Color fundus photograph · 2212 by 1659 pixels:
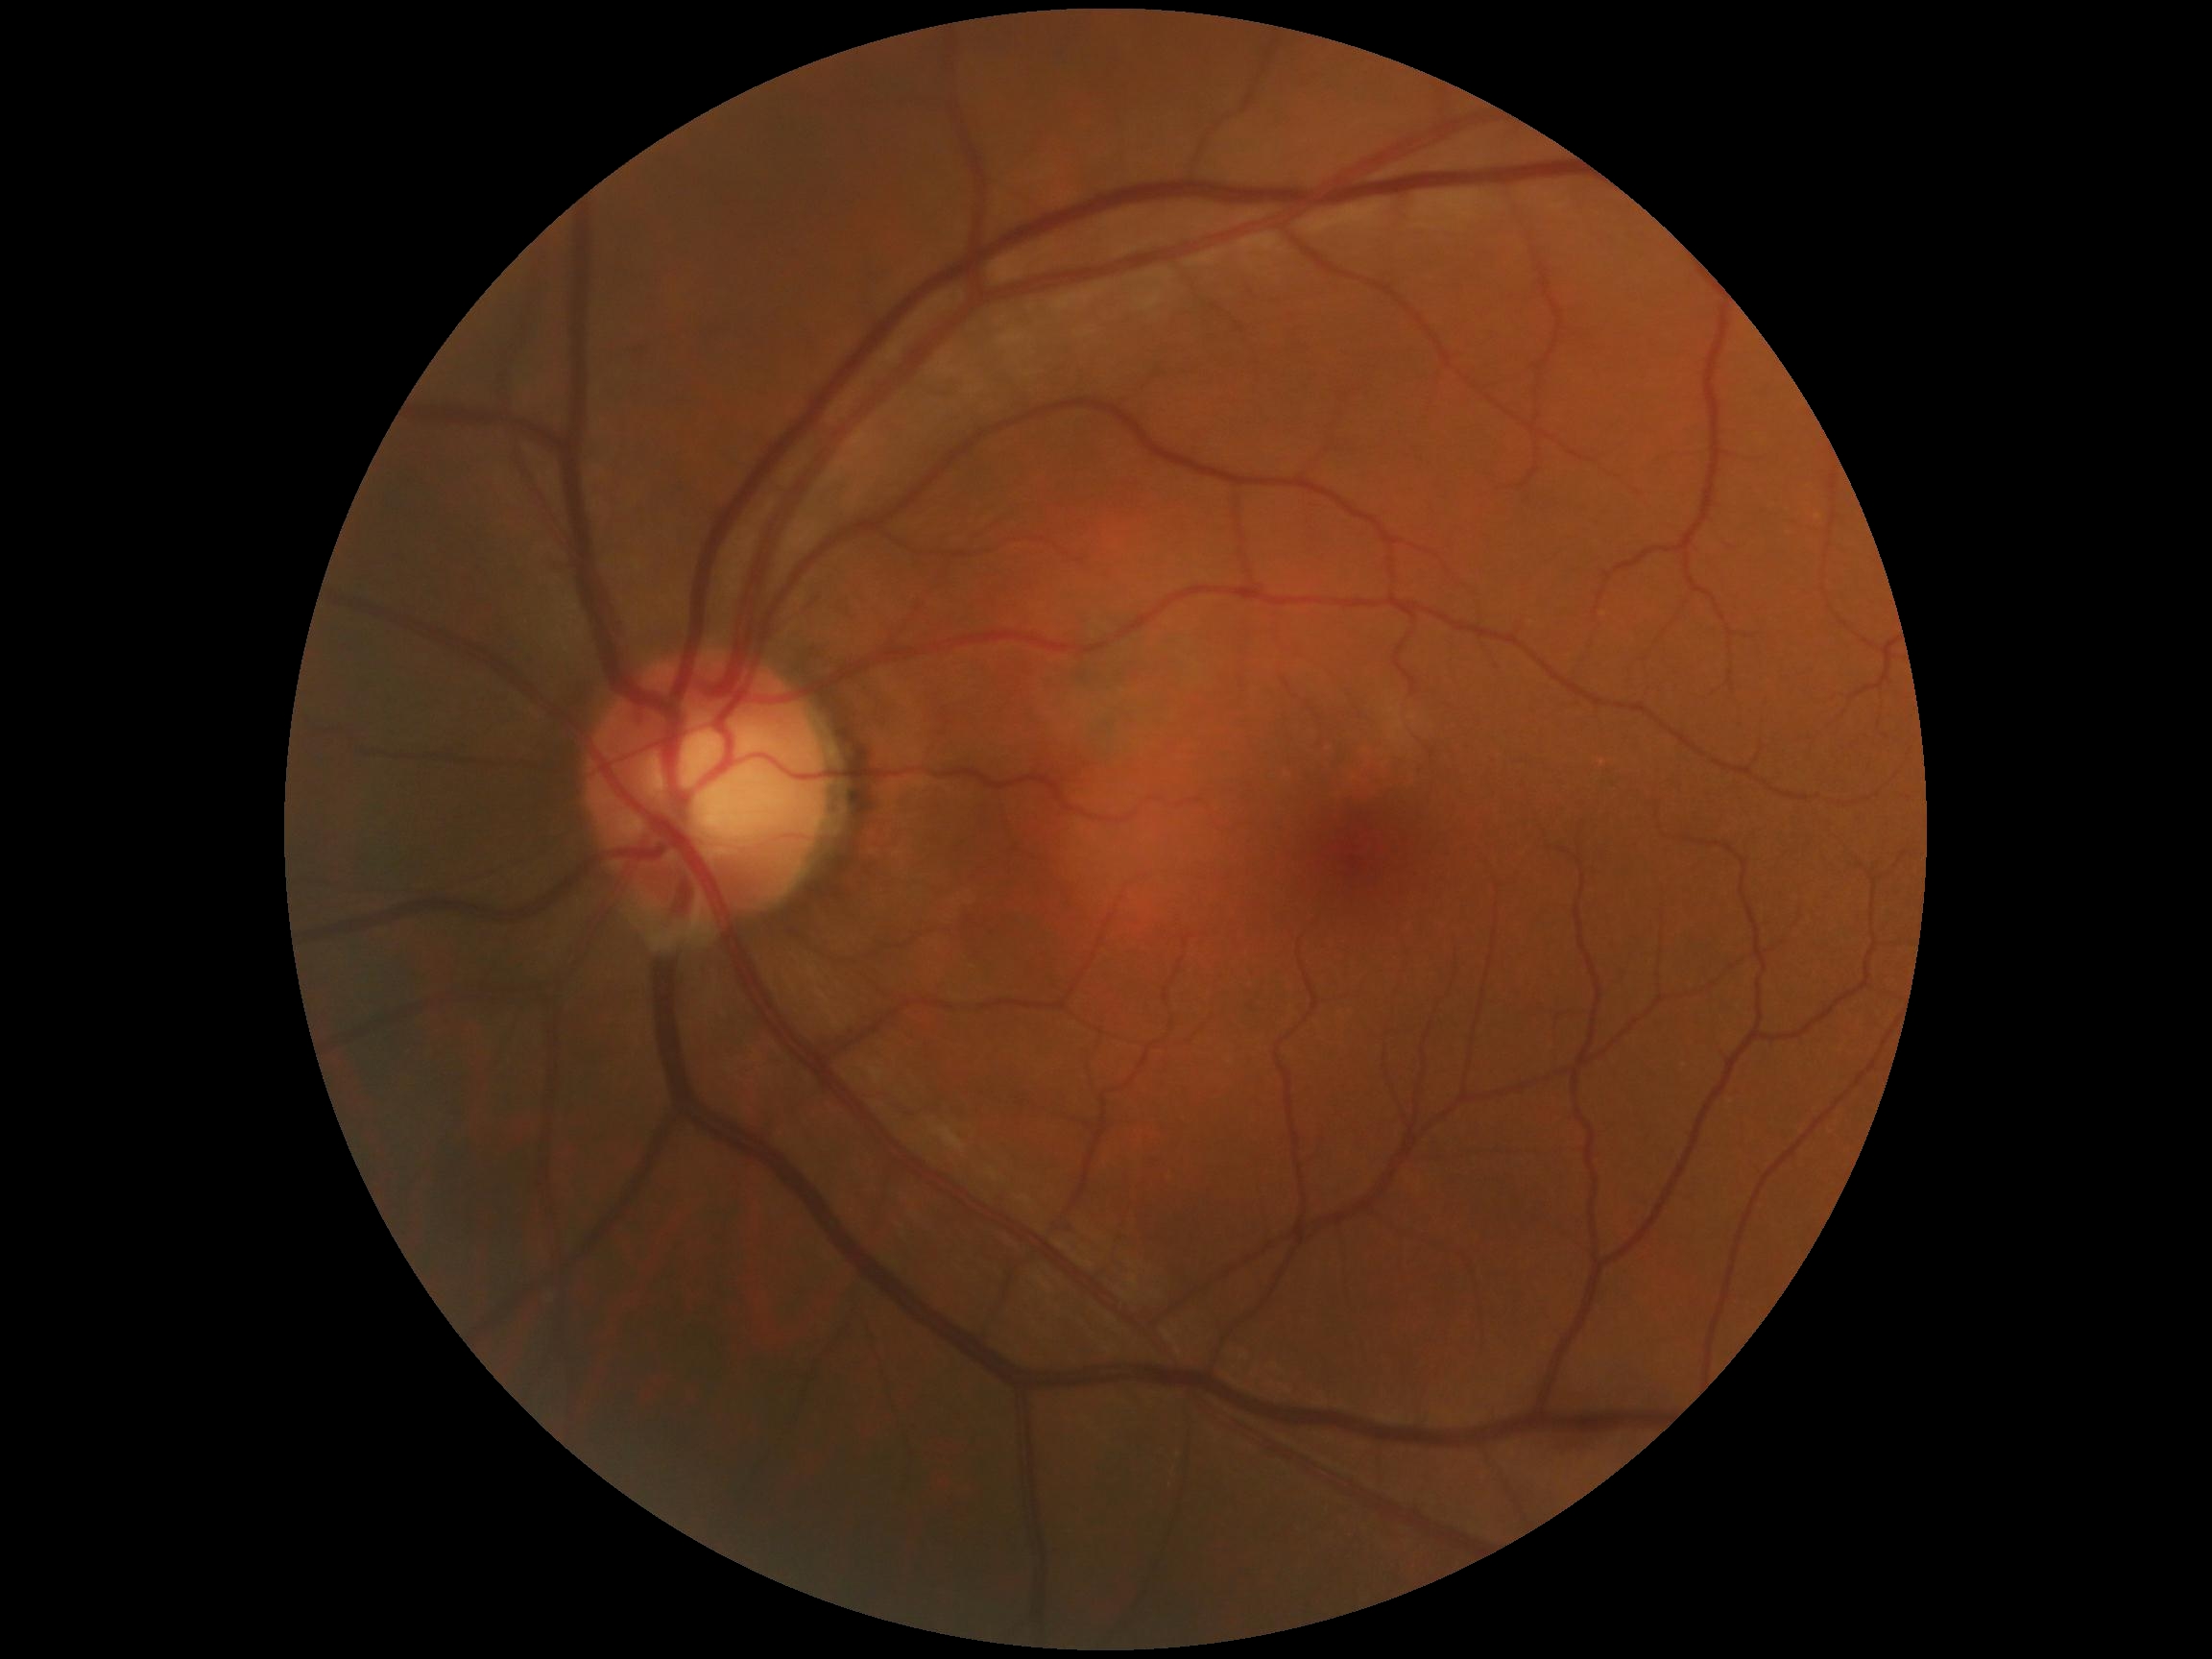 retinopathy: grade 0 (no apparent retinopathy), DR impression: no signs of DR.